Refractive error: +0 -2 x 82. Topcon TRC-NW400. Non-mydriatic. 30° FOV
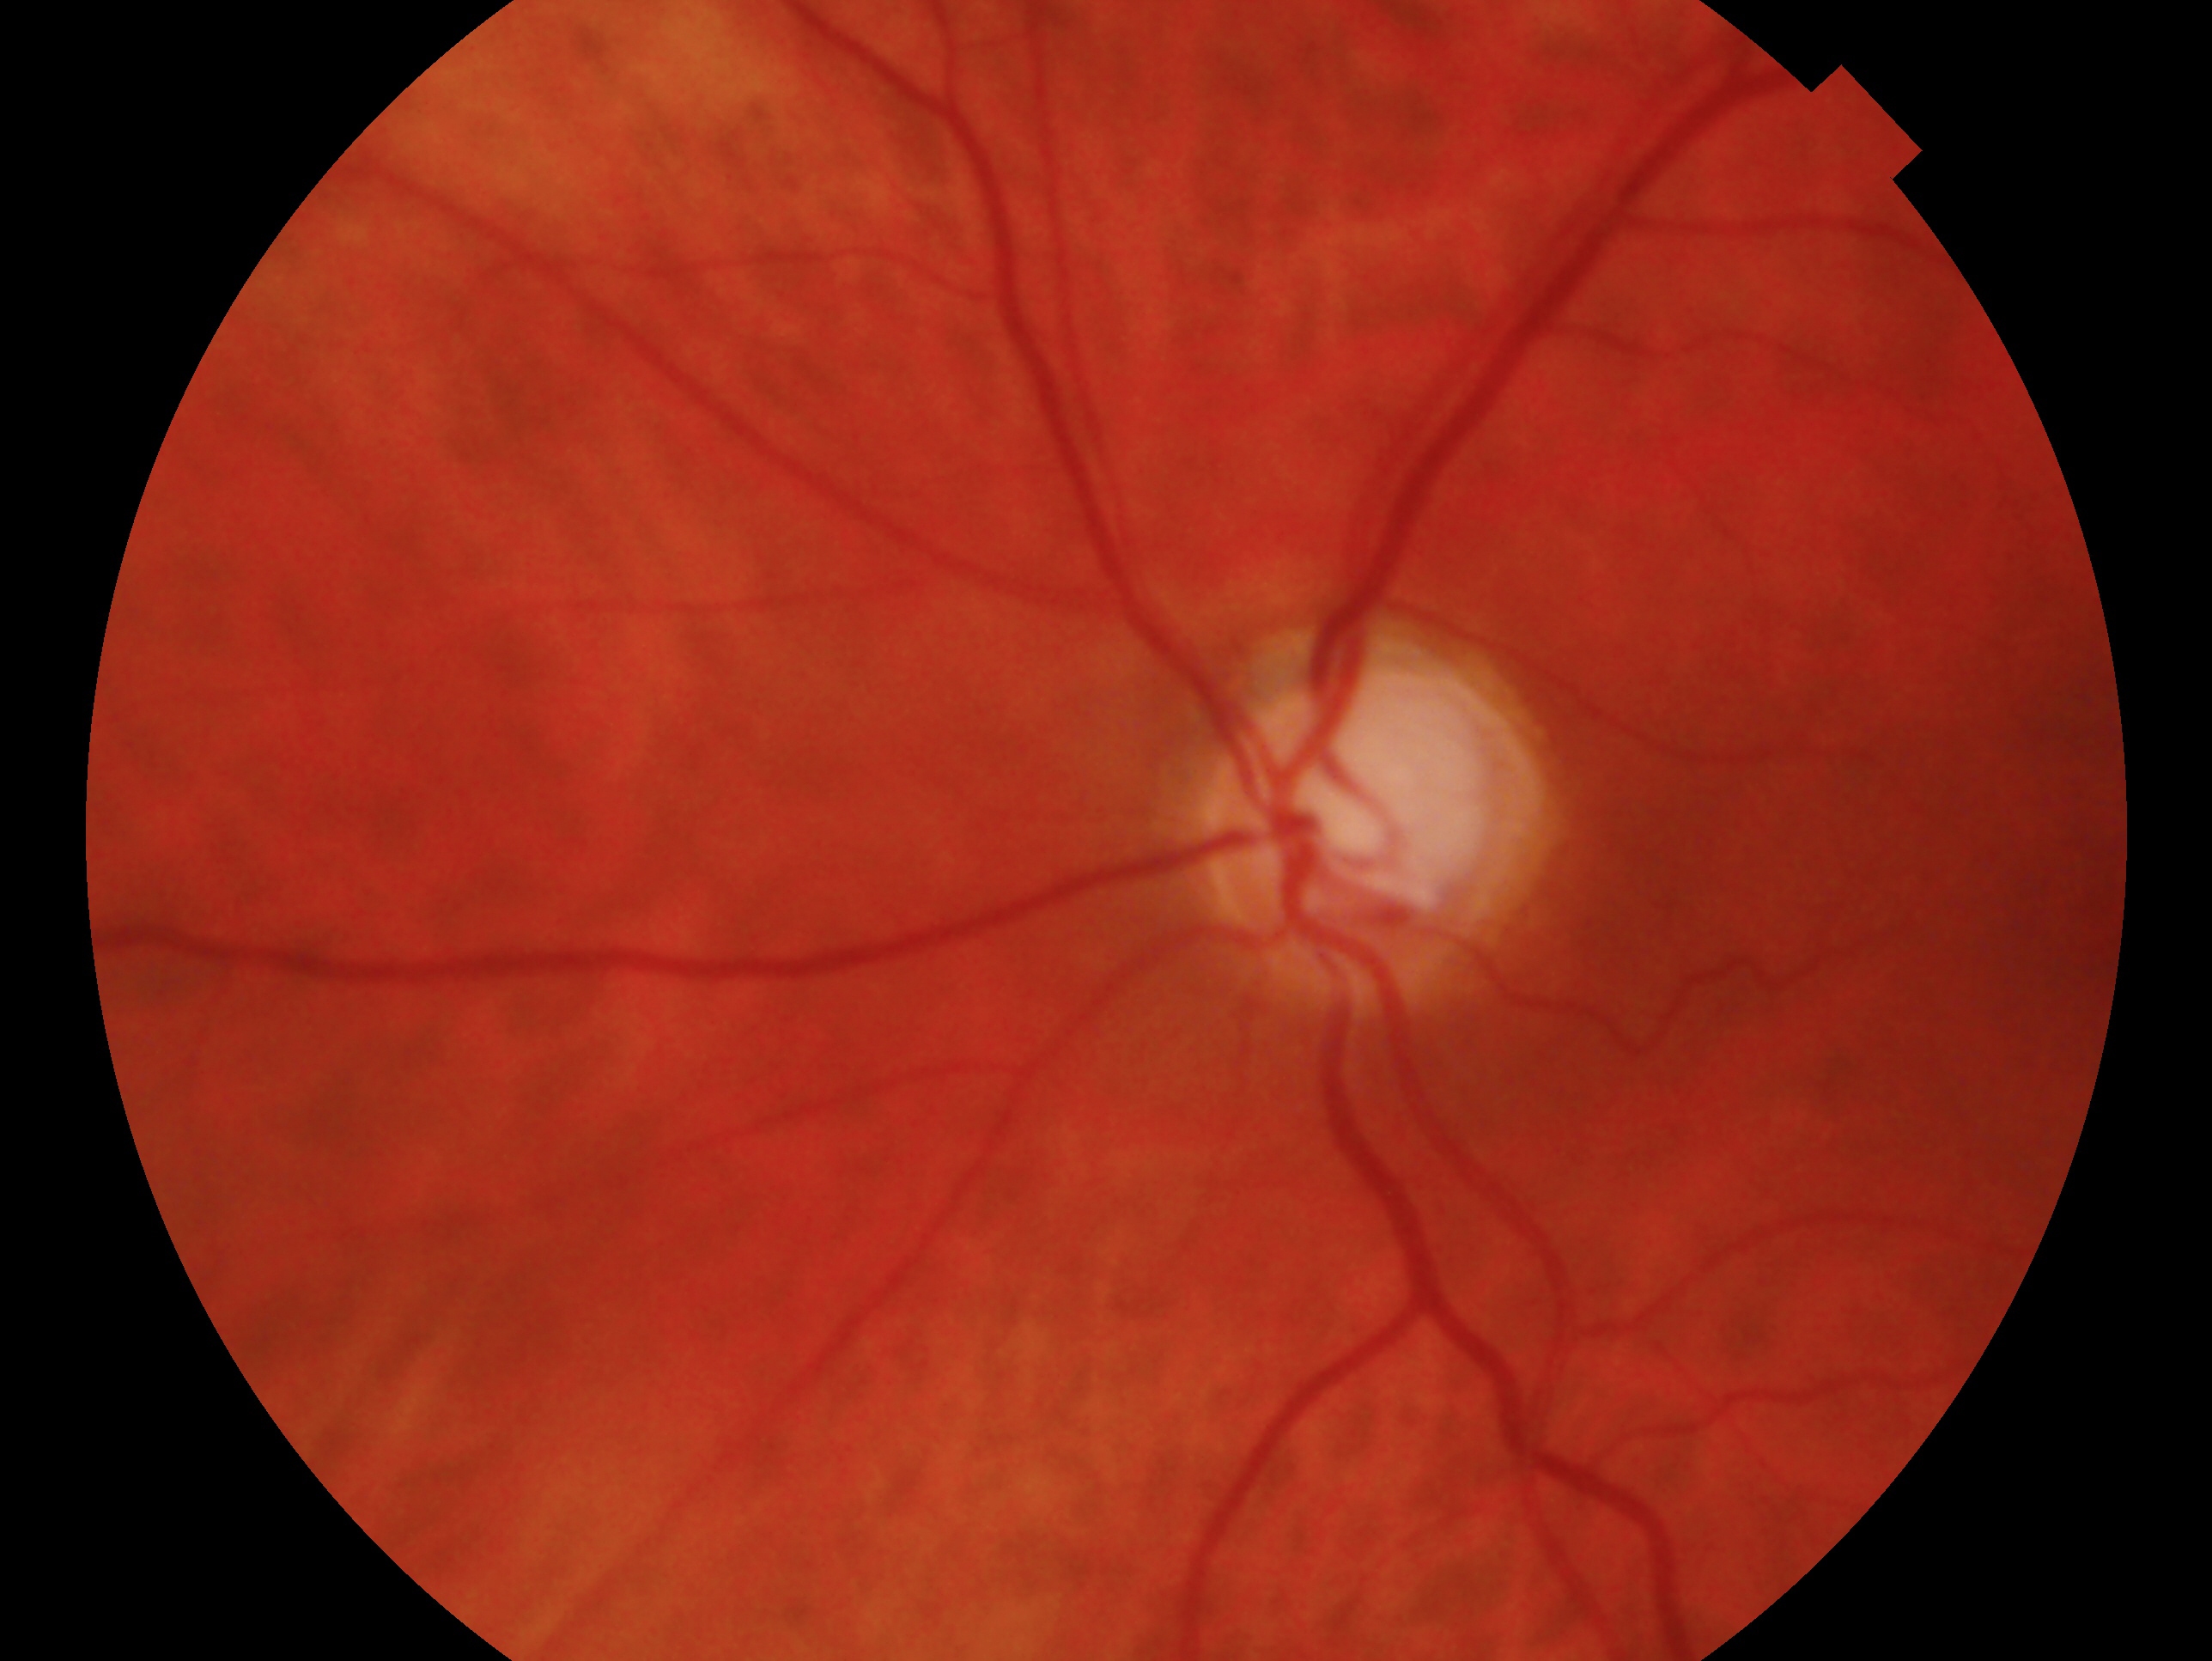

Glaucoma status — consistent with glaucoma.
The image shows the OS.